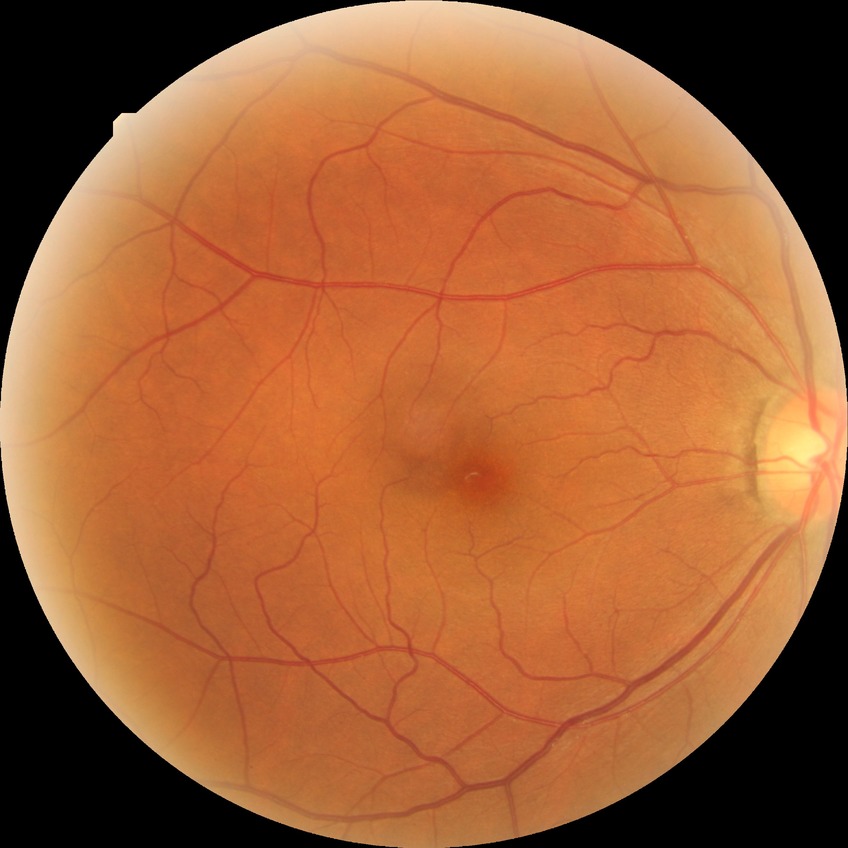

Modified Davis classification: no diabetic retinopathy.